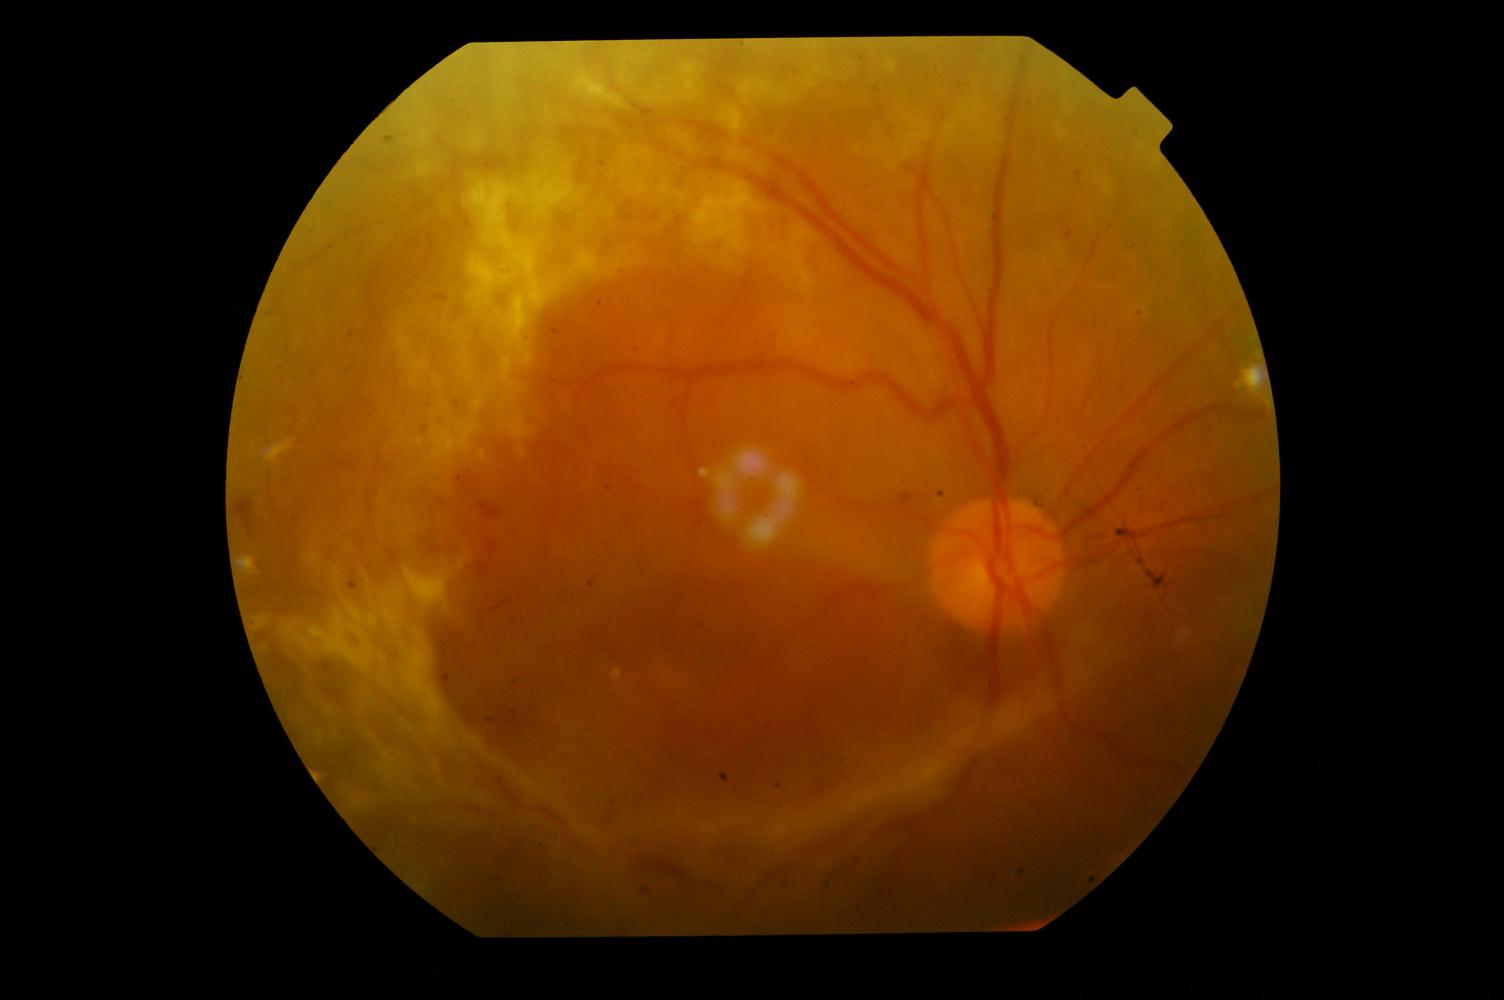 Findings: diabetic retinopathy.